2352x1568.
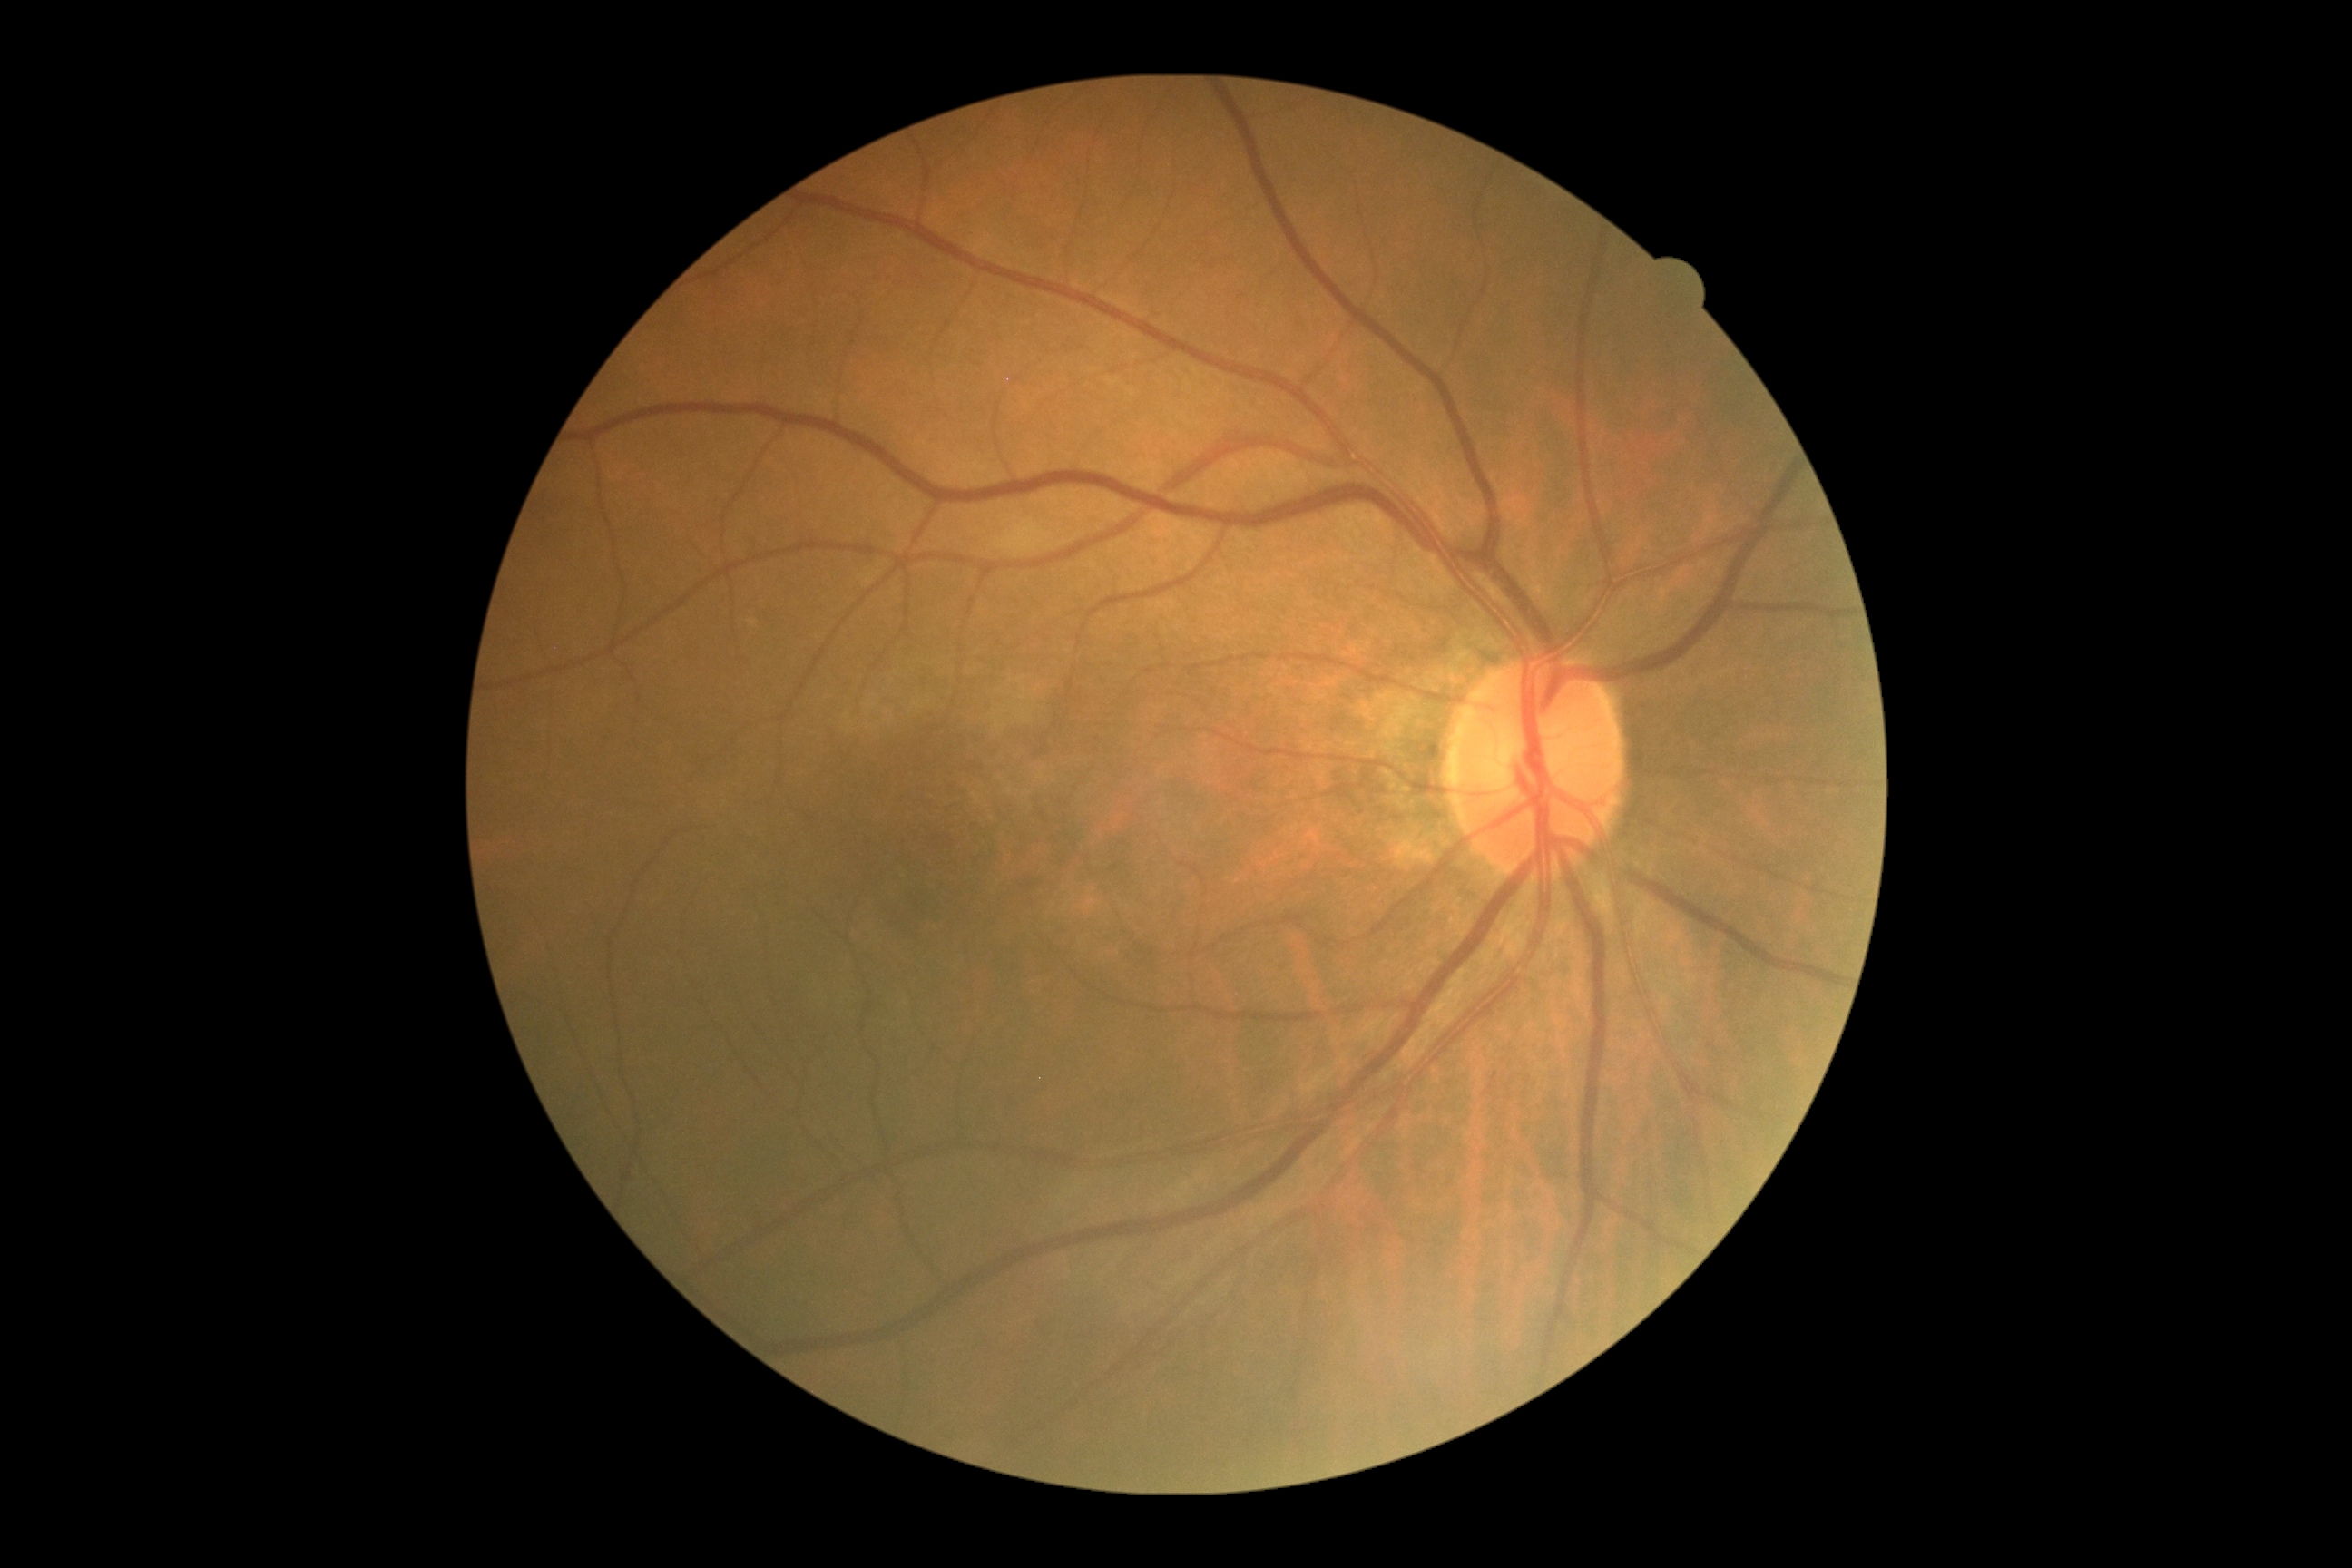

DR impression = no DR findings, diabetic retinopathy (DR) = grade 0 (no apparent retinopathy).